Pediatric wide-field fundus photograph
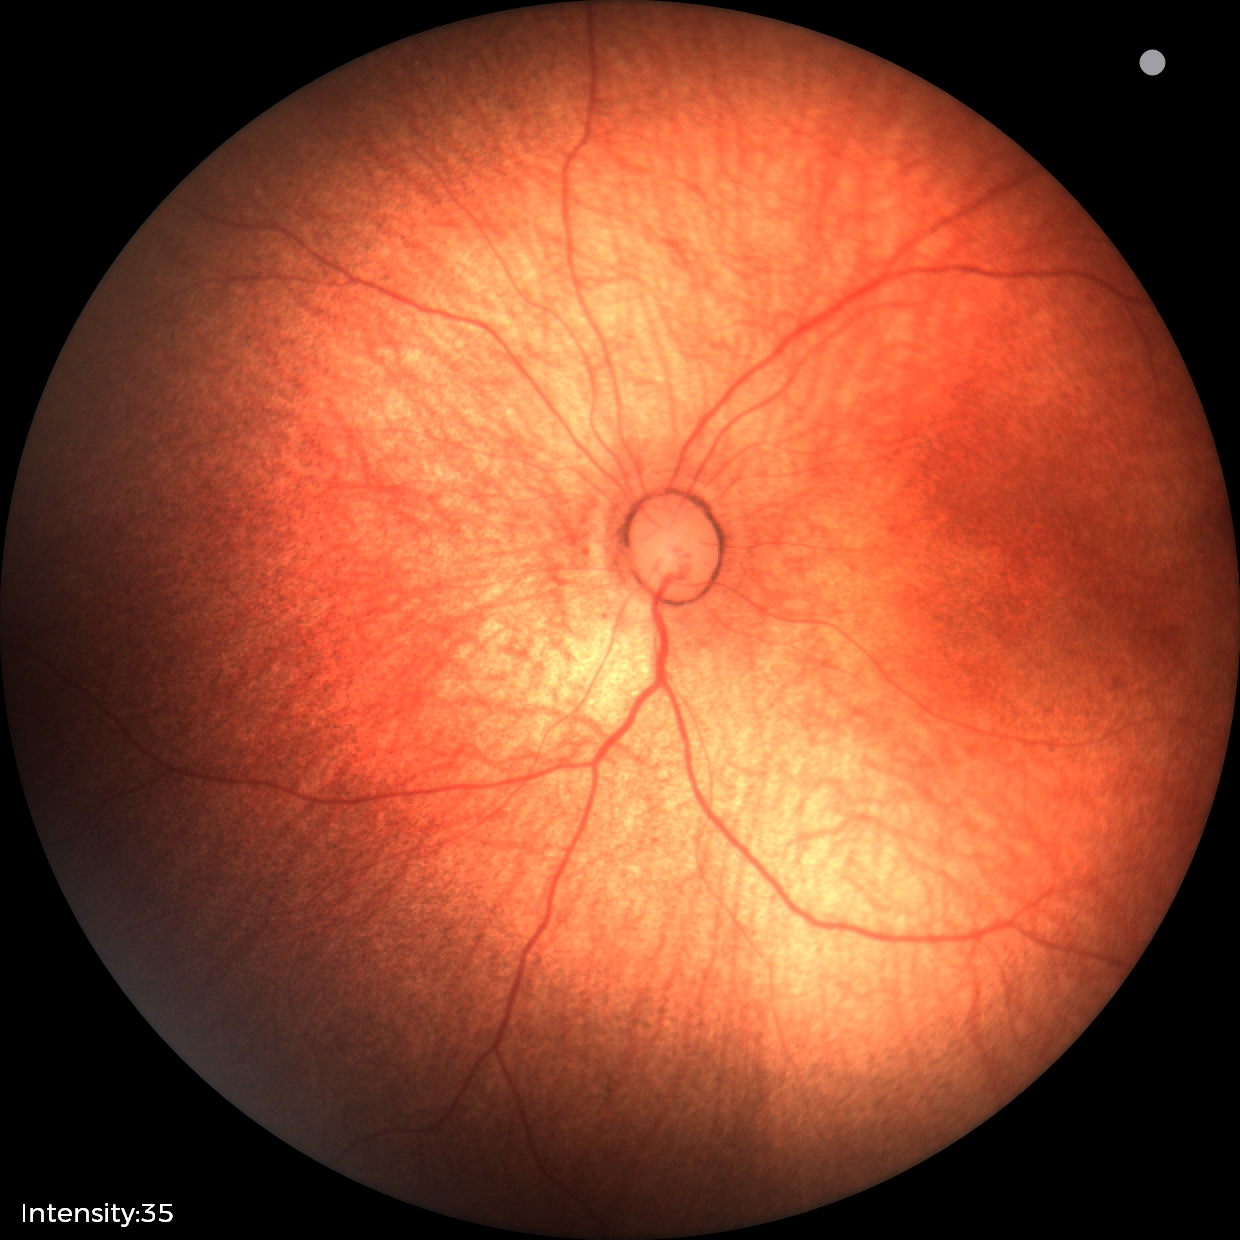

Screening diagnosis: physiological appearance with no retinal pathology.